Mydriatic acquisition, optic disc photograph, 442 by 442 pixels — 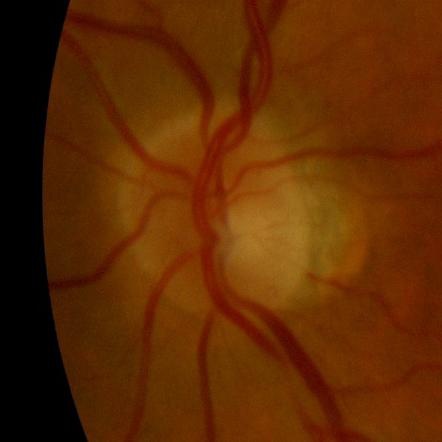
No glaucomatous damage.